848x848
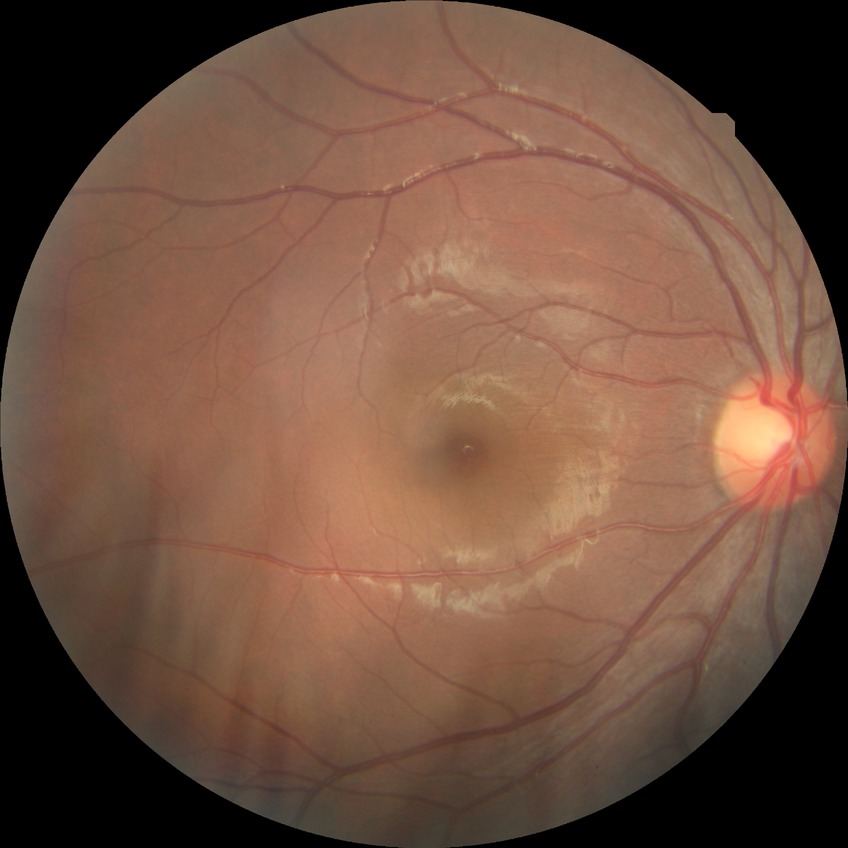

davis_grade: NDR